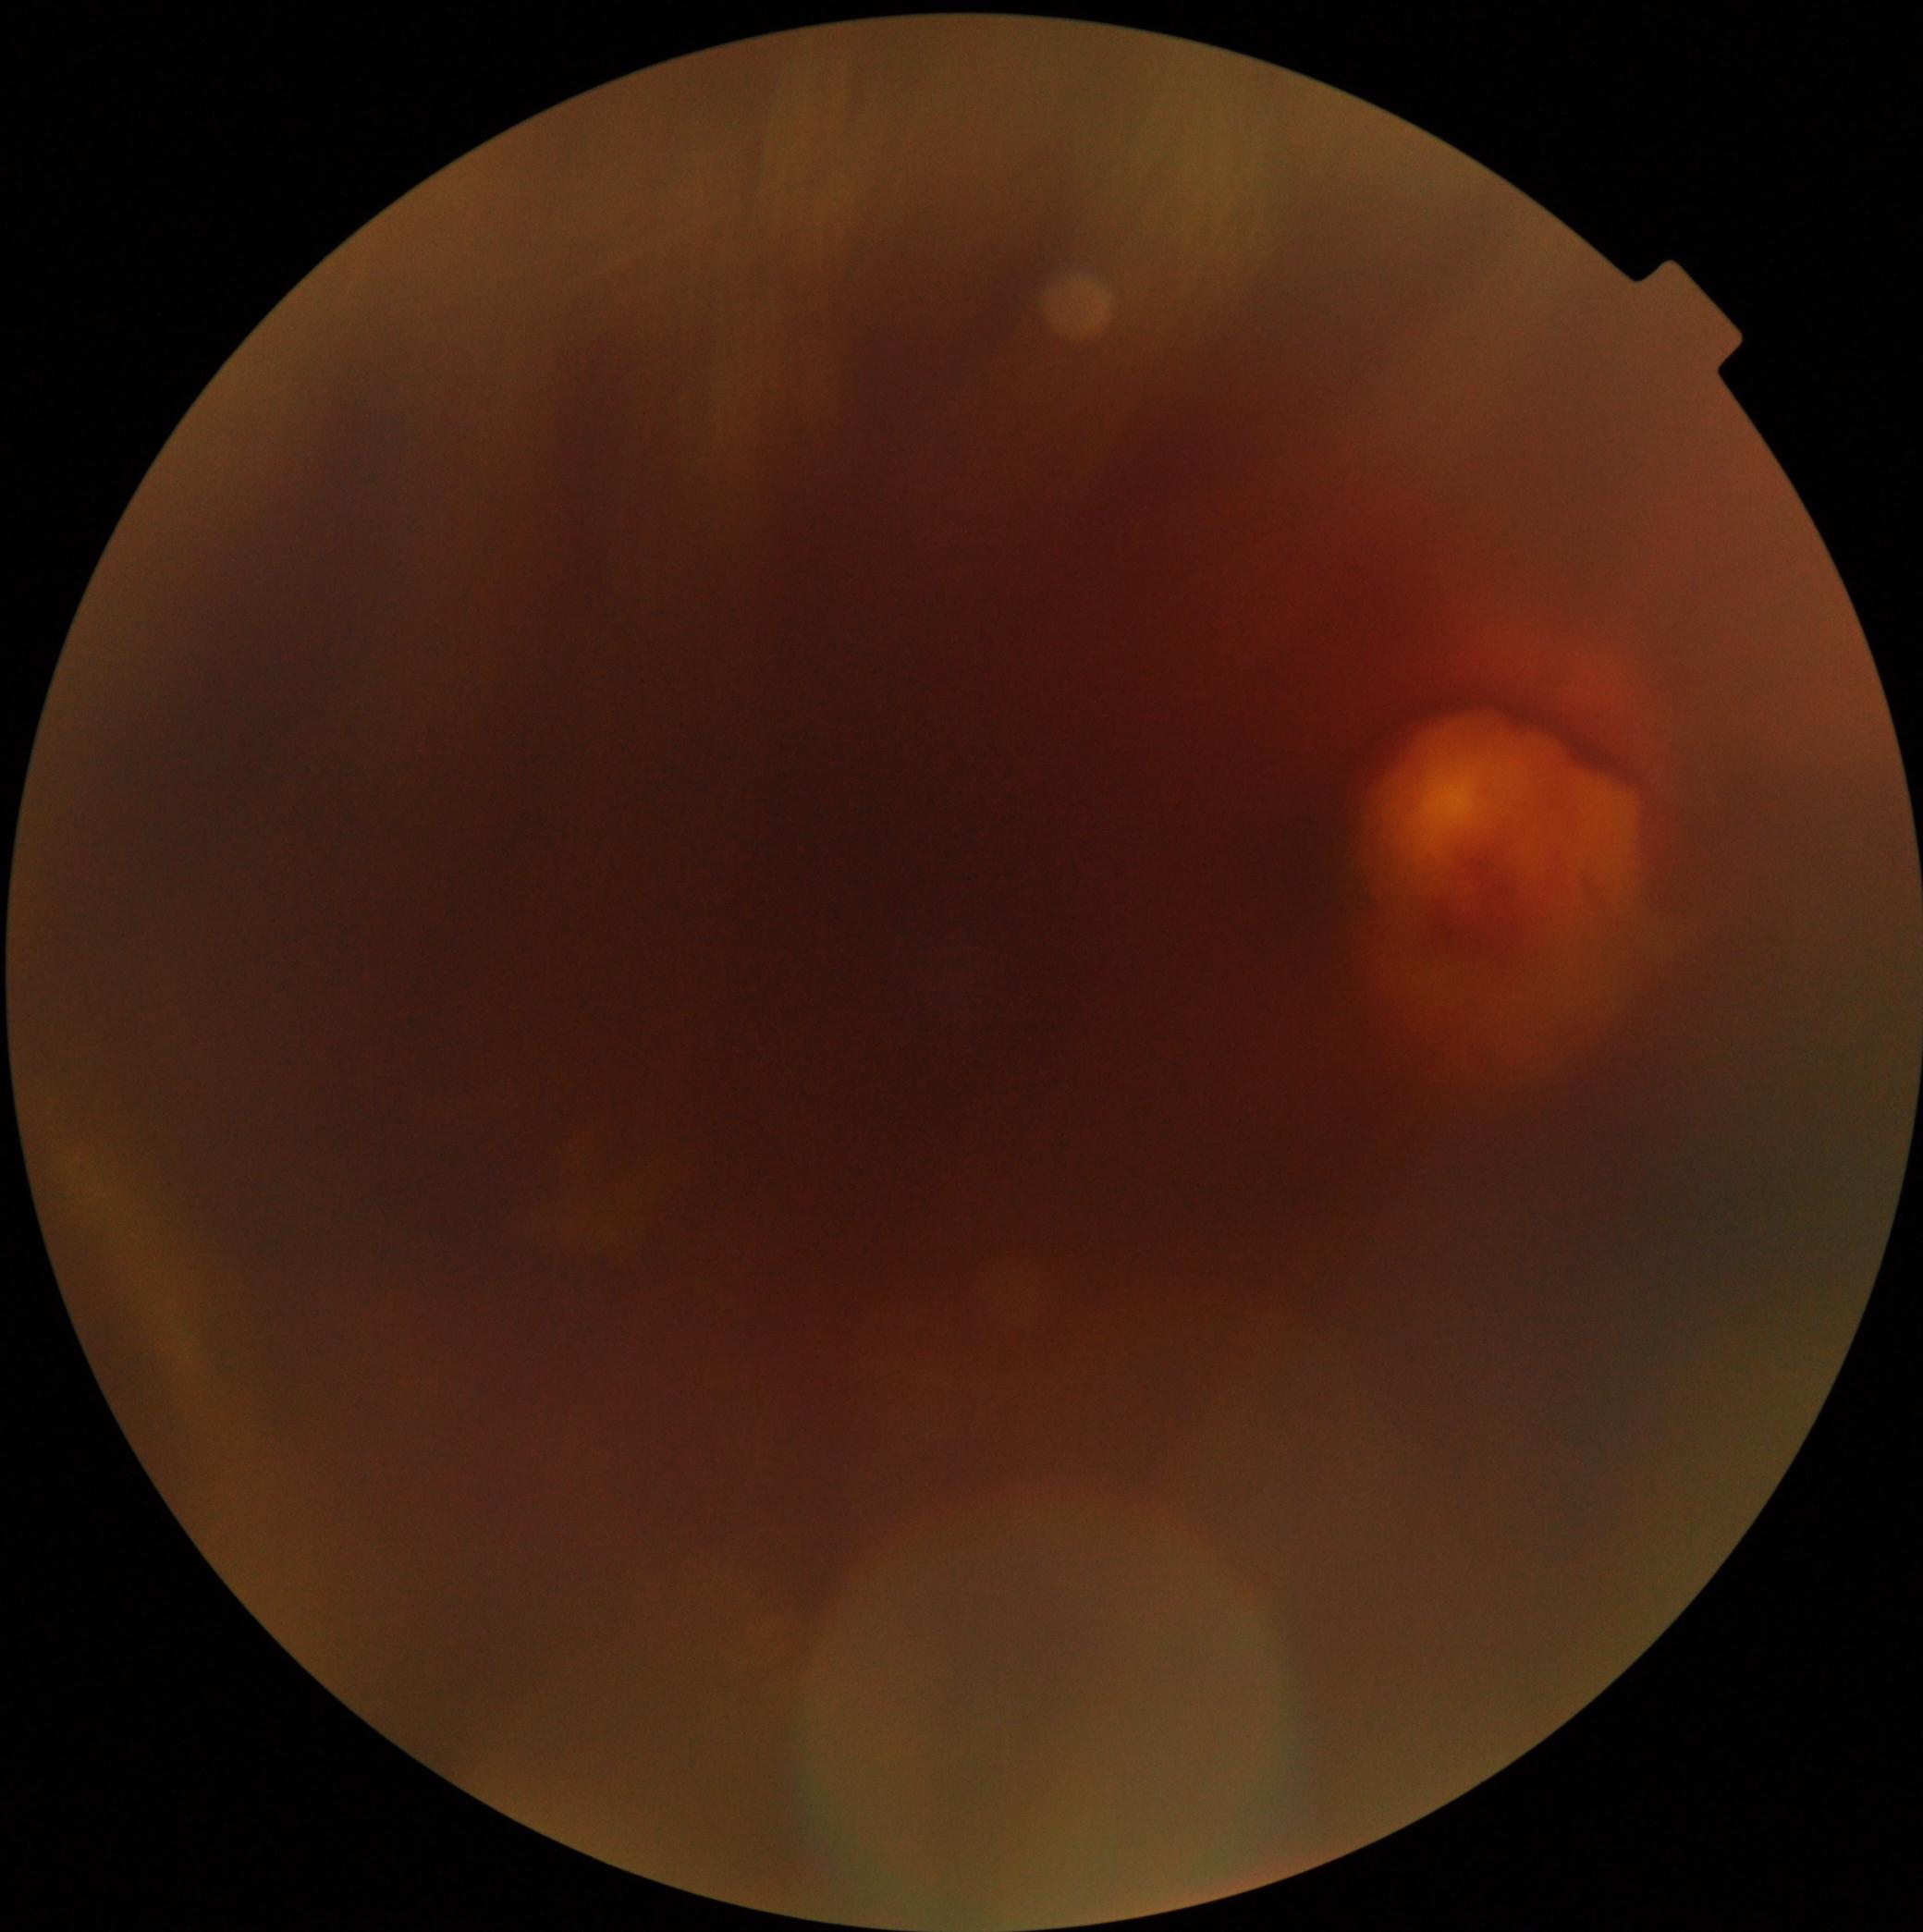
Annotations:
• DR stage: grade 4 (PDR)